Fundus photo. 1932 by 1932 pixels: 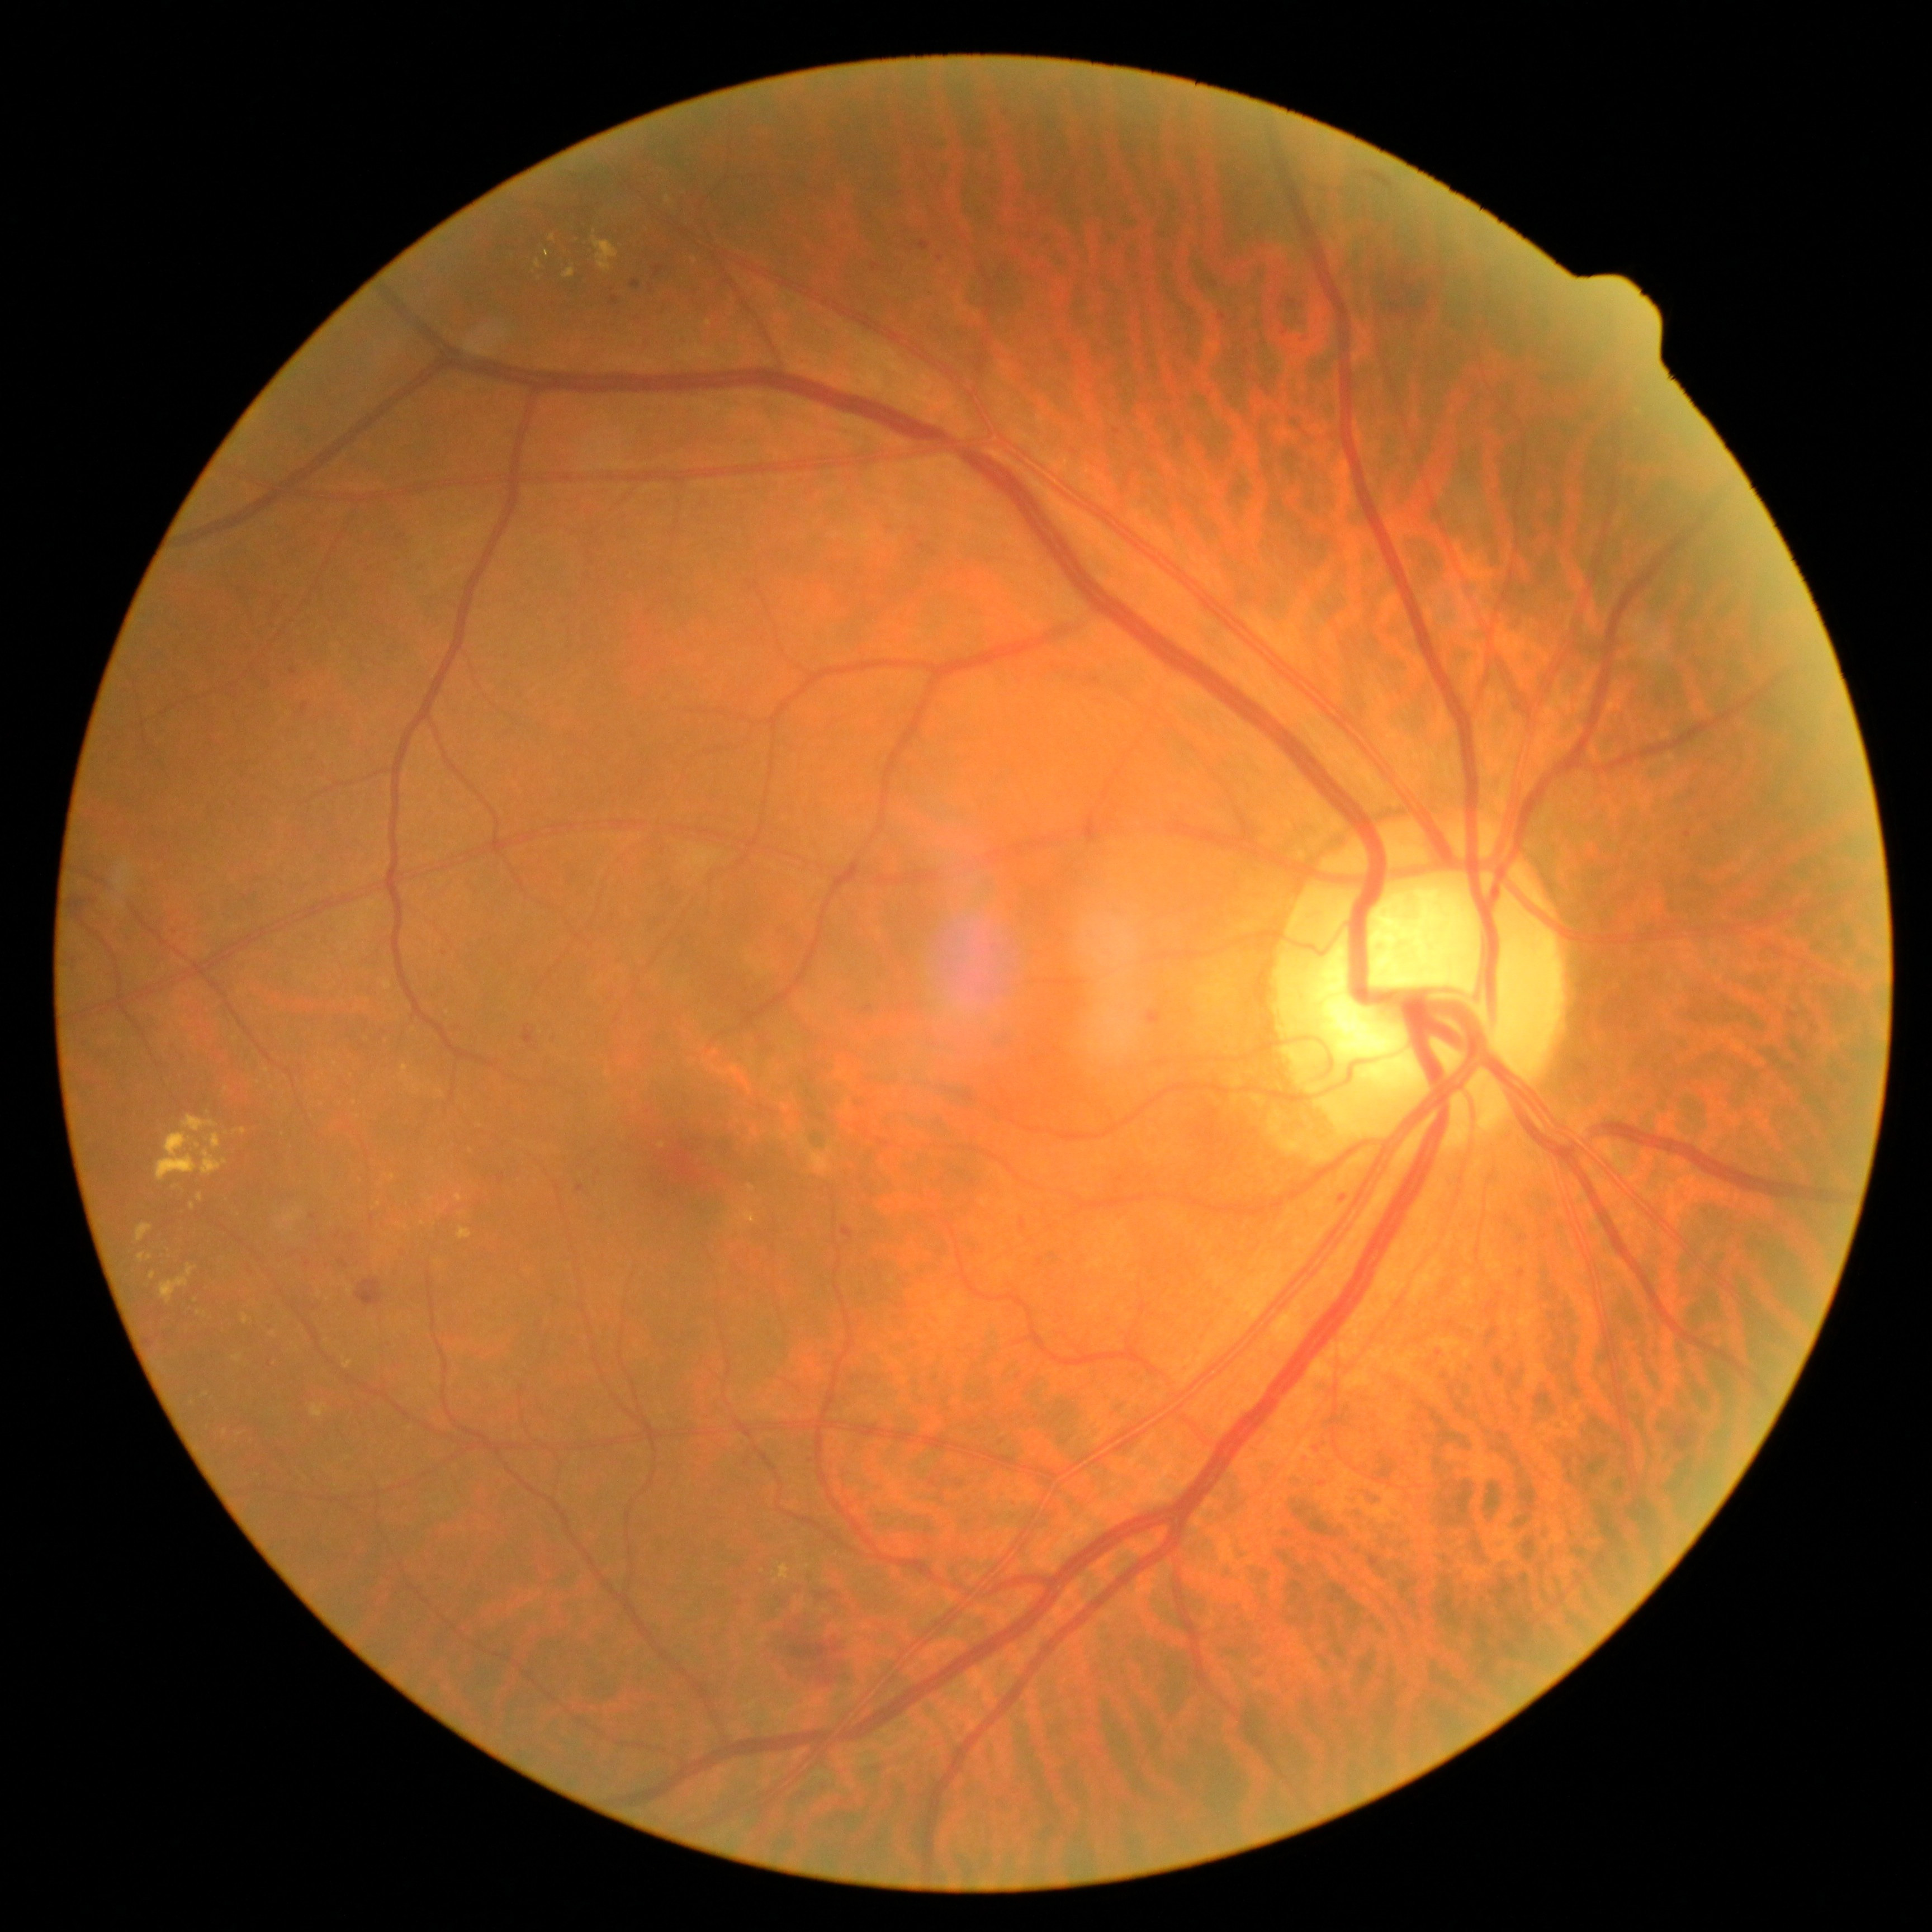

Diabetic retinopathy (DR): grade 2.
Microaneurysms (MAs) include box(576, 1183, 585, 1192); box(349, 1234, 358, 1242); box(1812, 1024, 1817, 1033); box(499, 1175, 506, 1183); box(1002, 111, 1010, 117); box(1788, 1011, 1800, 1020); box(920, 241, 932, 250); box(290, 668, 297, 676); box(656, 267, 665, 277); box(842, 1227, 854, 1239).
MAs (small, approximate centers) near (1247,353); (338,1235); (739,1603); (314,1216).
Hard exudates (EXs) include box(139, 1254, 144, 1263); box(202, 1149, 226, 1177); box(137, 1223, 154, 1243); box(563, 268, 576, 279); box(743, 1210, 756, 1224); box(196, 1311, 207, 1317); box(311, 1403, 328, 1417); box(160, 1264, 196, 1304); box(234, 1355, 243, 1363).
EXs (small, approximate centers) near (459,1198); (244,1131); (552,238); (193,1207); (201,1198); (751,1188); (662,1145); (149,1257).